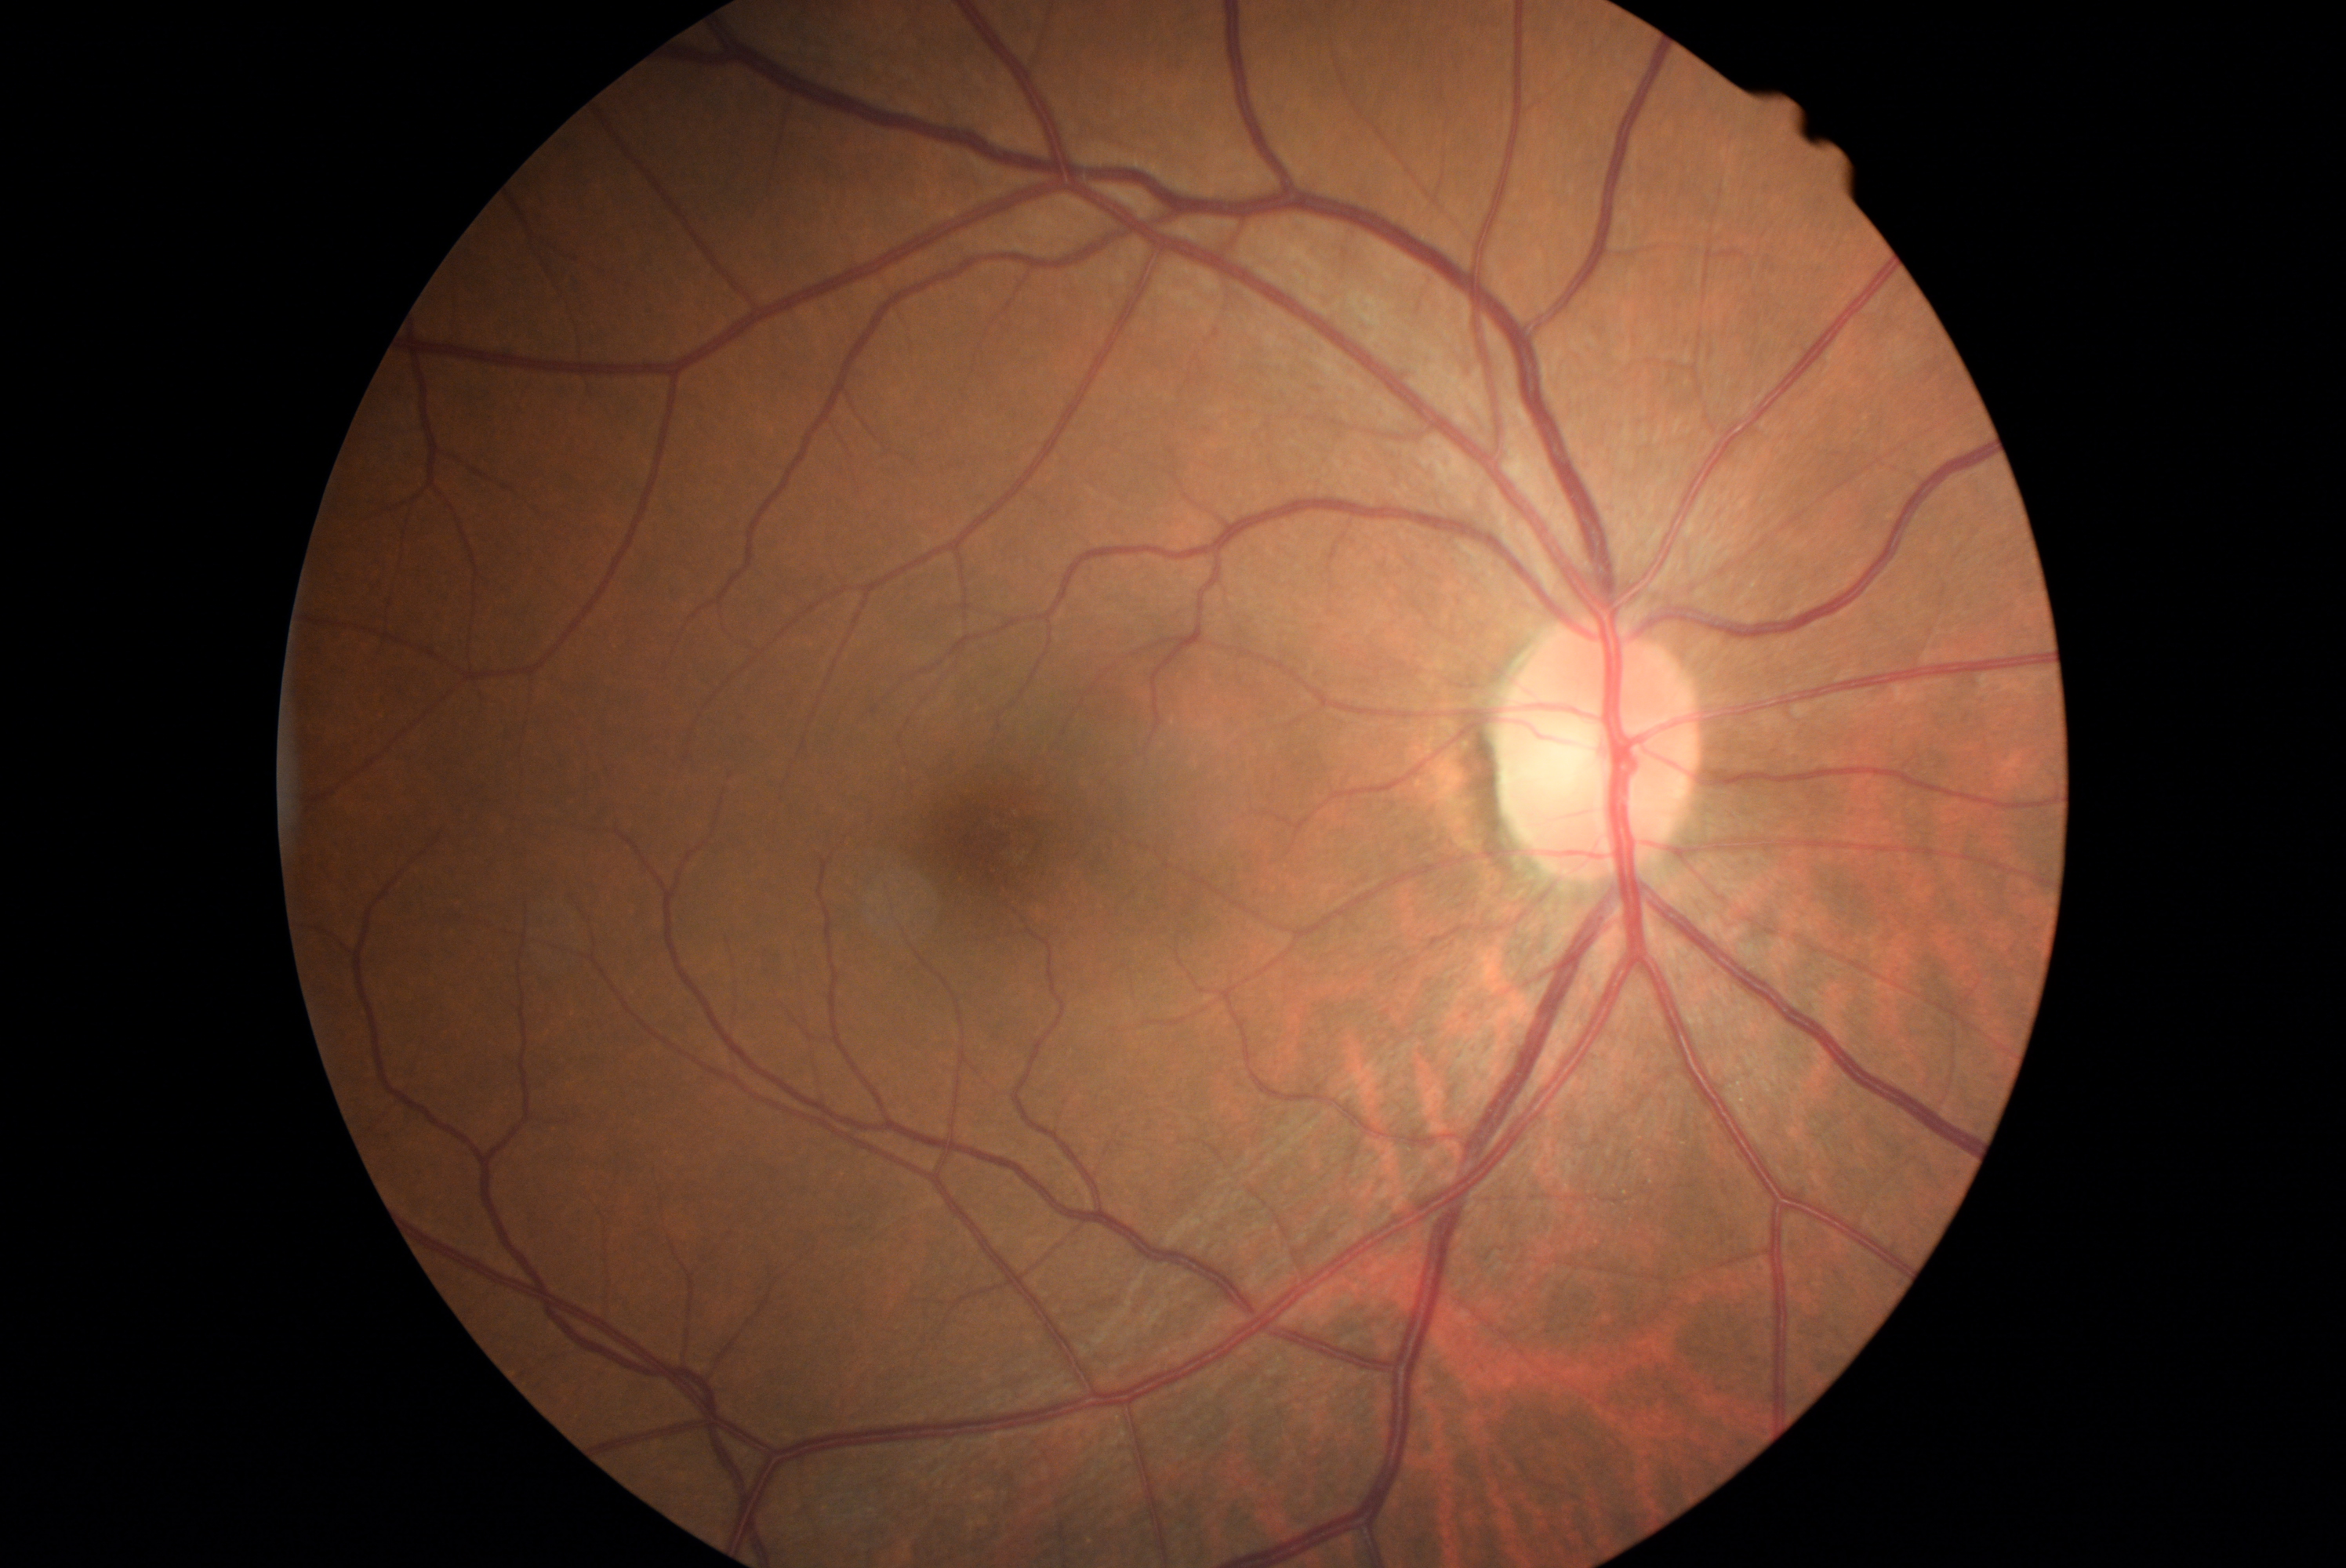 Findings:
• DR stage: grade 0
• DR impression: no DR findings